45-degree field of view.
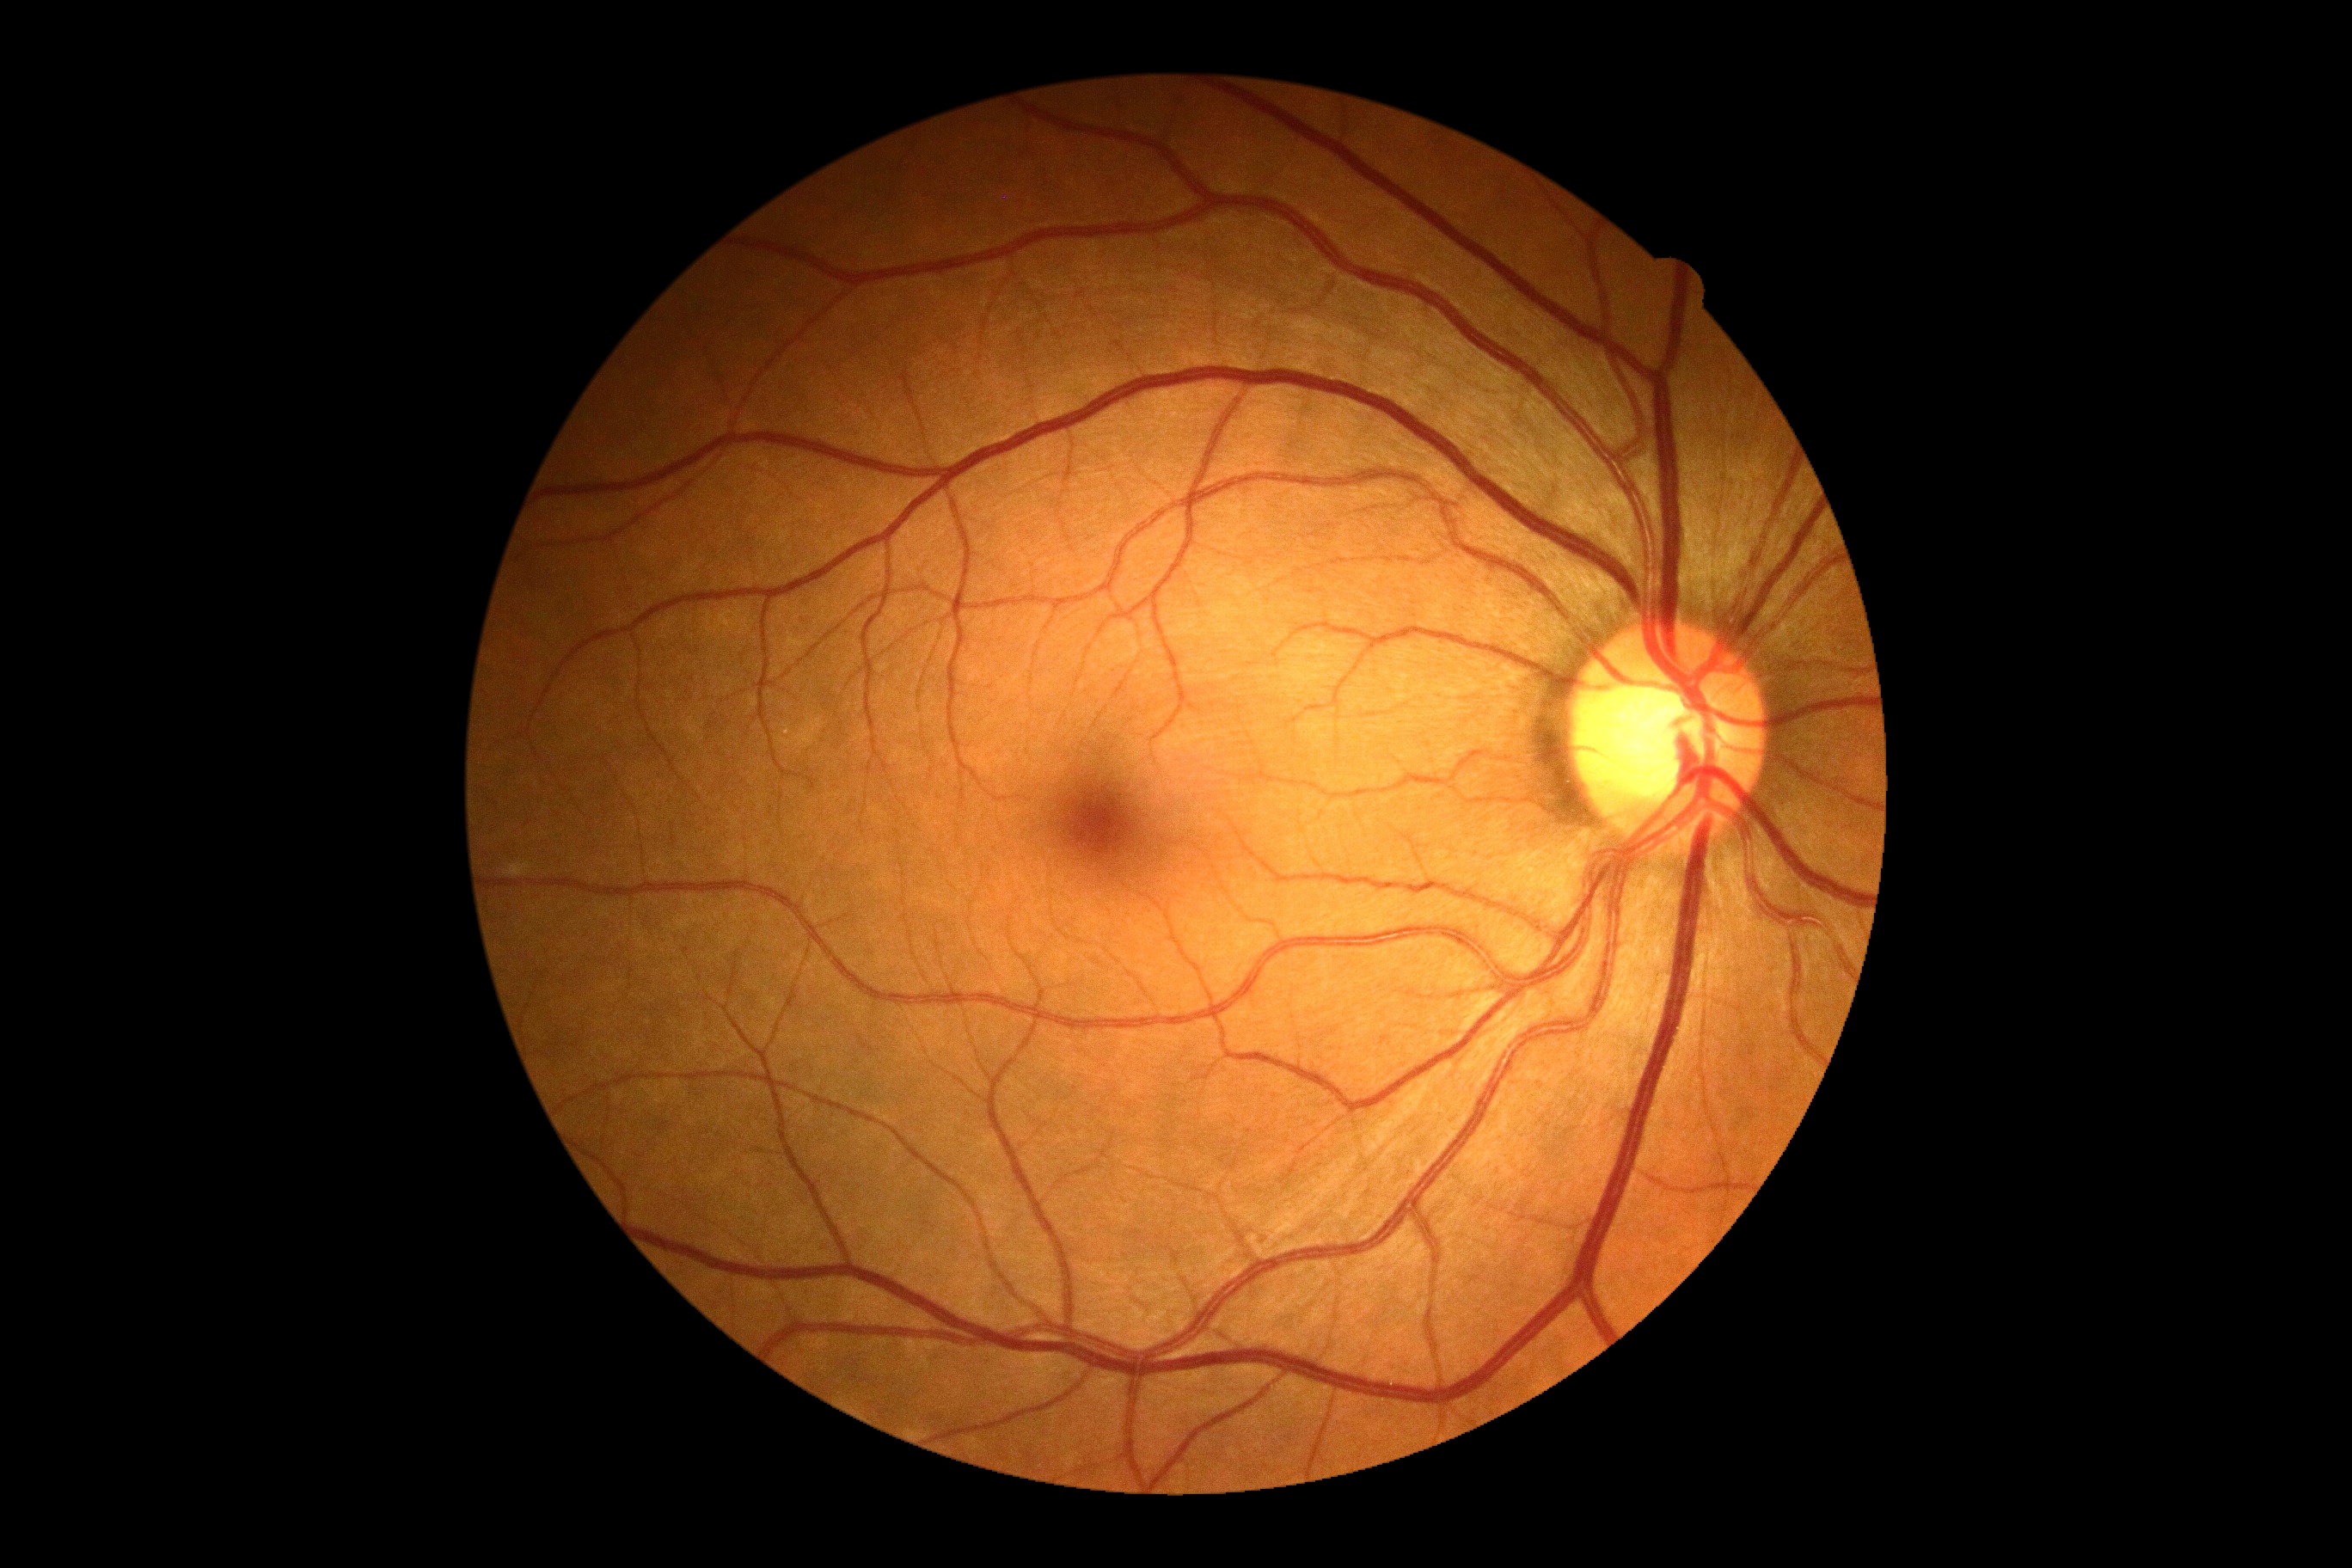 No DR findings. Diabetic retinopathy is no apparent retinopathy (grade 0).